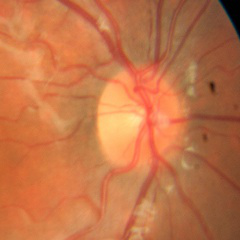 No signs of glaucoma.